Nonmydriatic fundus photograph, 848 by 848 pixels, 45 degree fundus photograph, modified Davis classification, CFP: 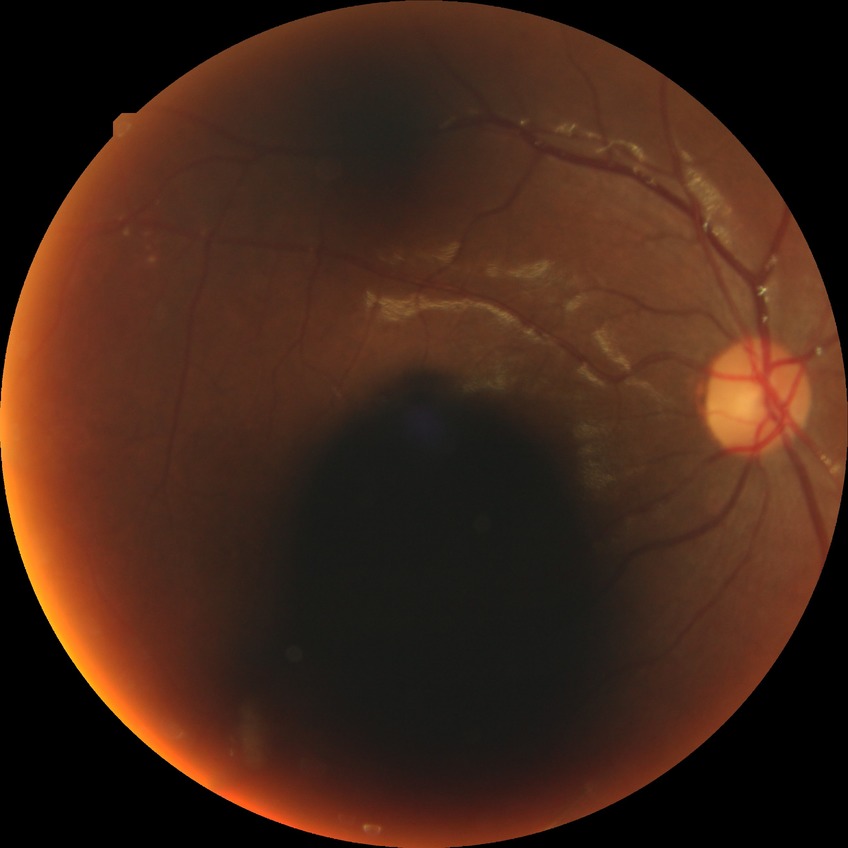
Davis grading = pre-proliferative diabetic retinopathy.